Color fundus image:
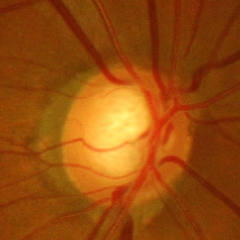

Advanced-stage glaucoma.